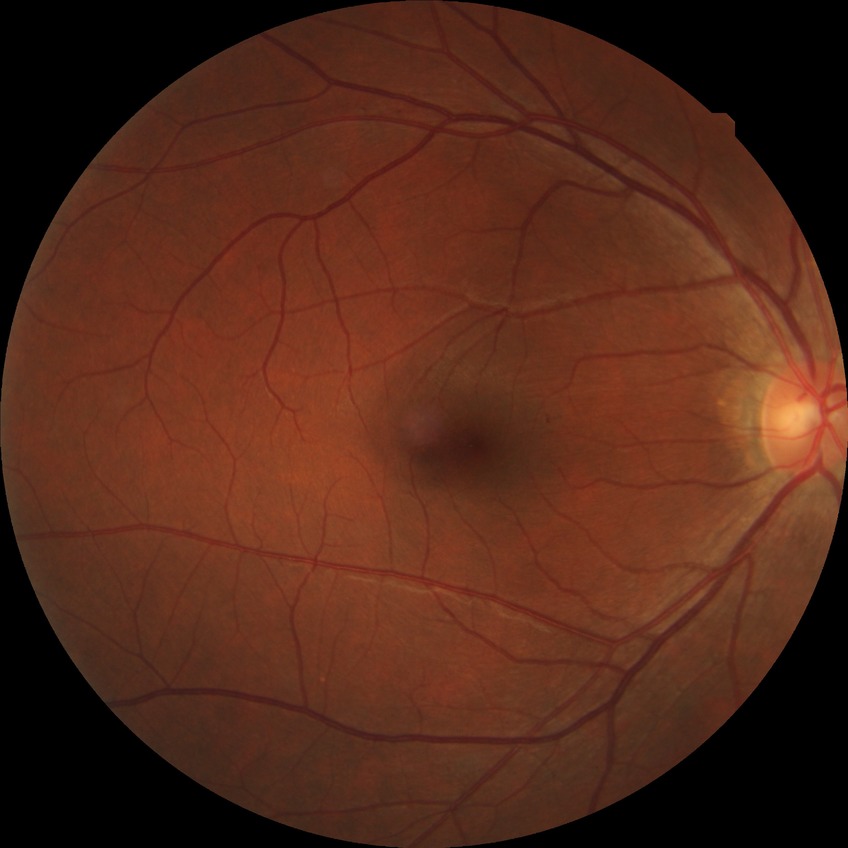

Diabetic retinopathy (DR) is NDR (no diabetic retinopathy).